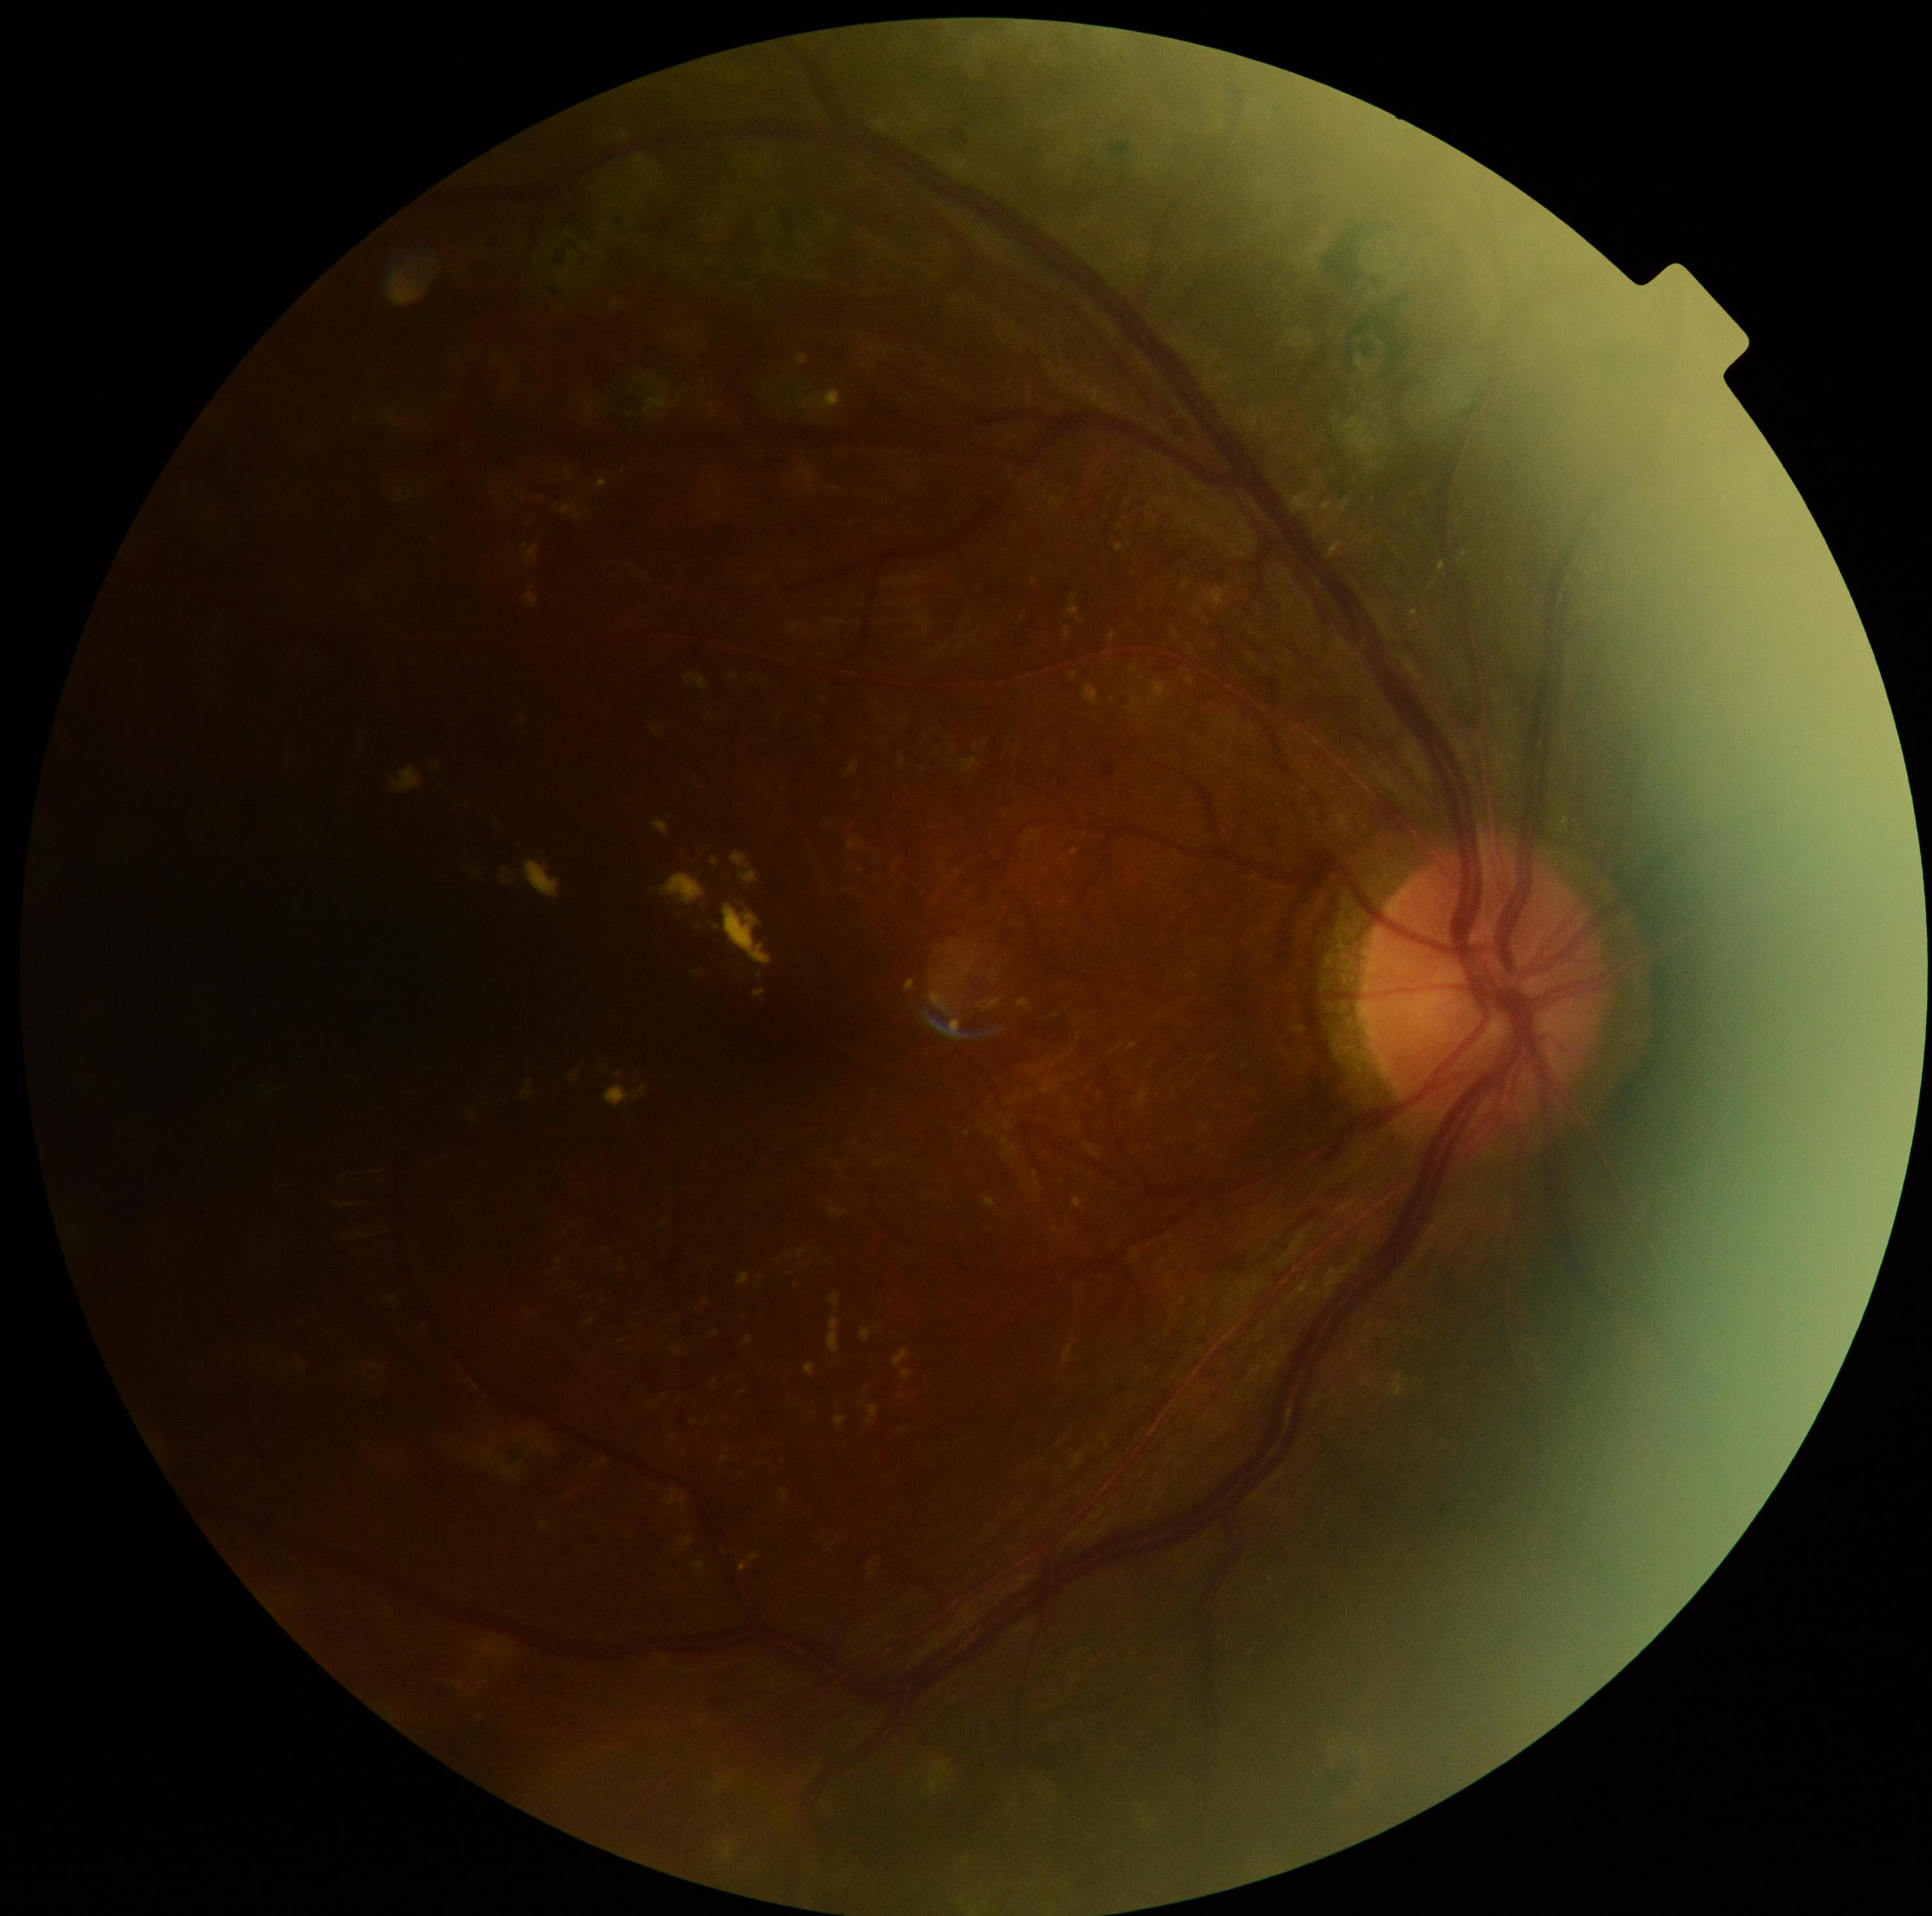

DR: 2.